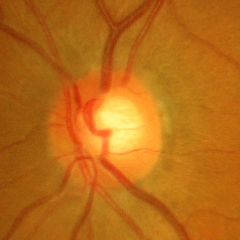
Glaucoma diagnosis: no evidence of glaucoma.